Fundus photo:
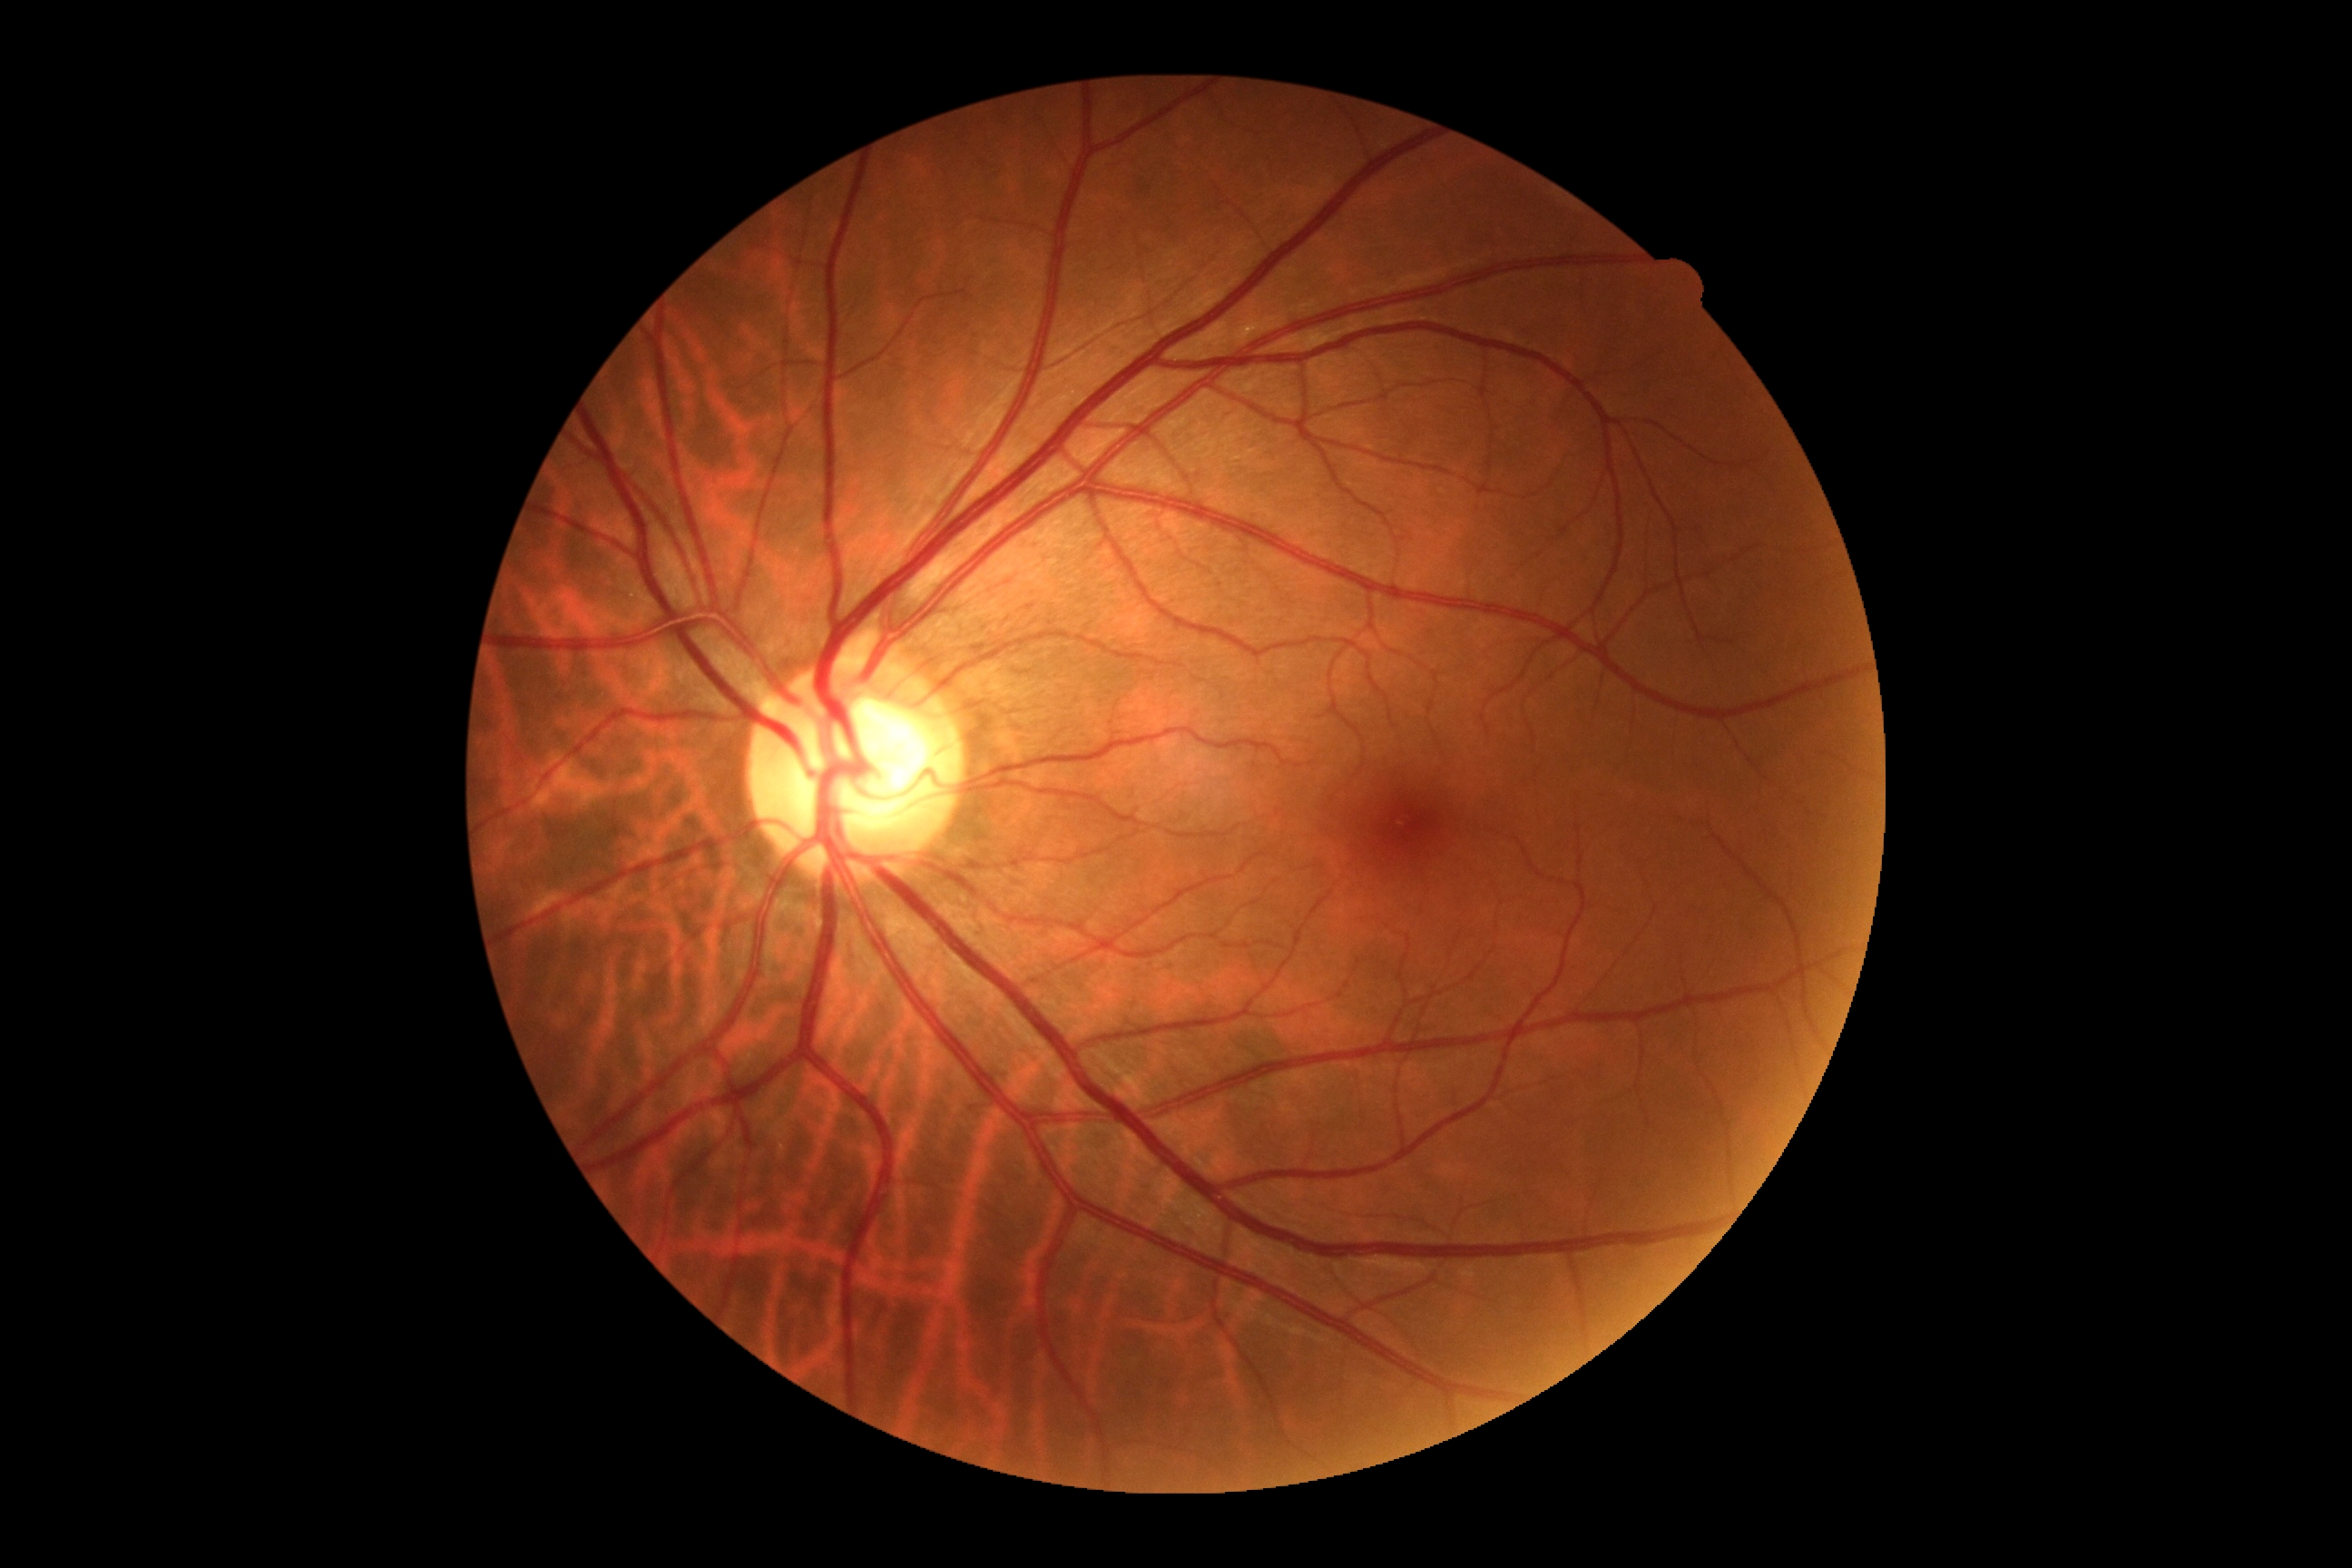

DR grade = 0 — no visible signs of diabetic retinopathy.